2212x1659px.
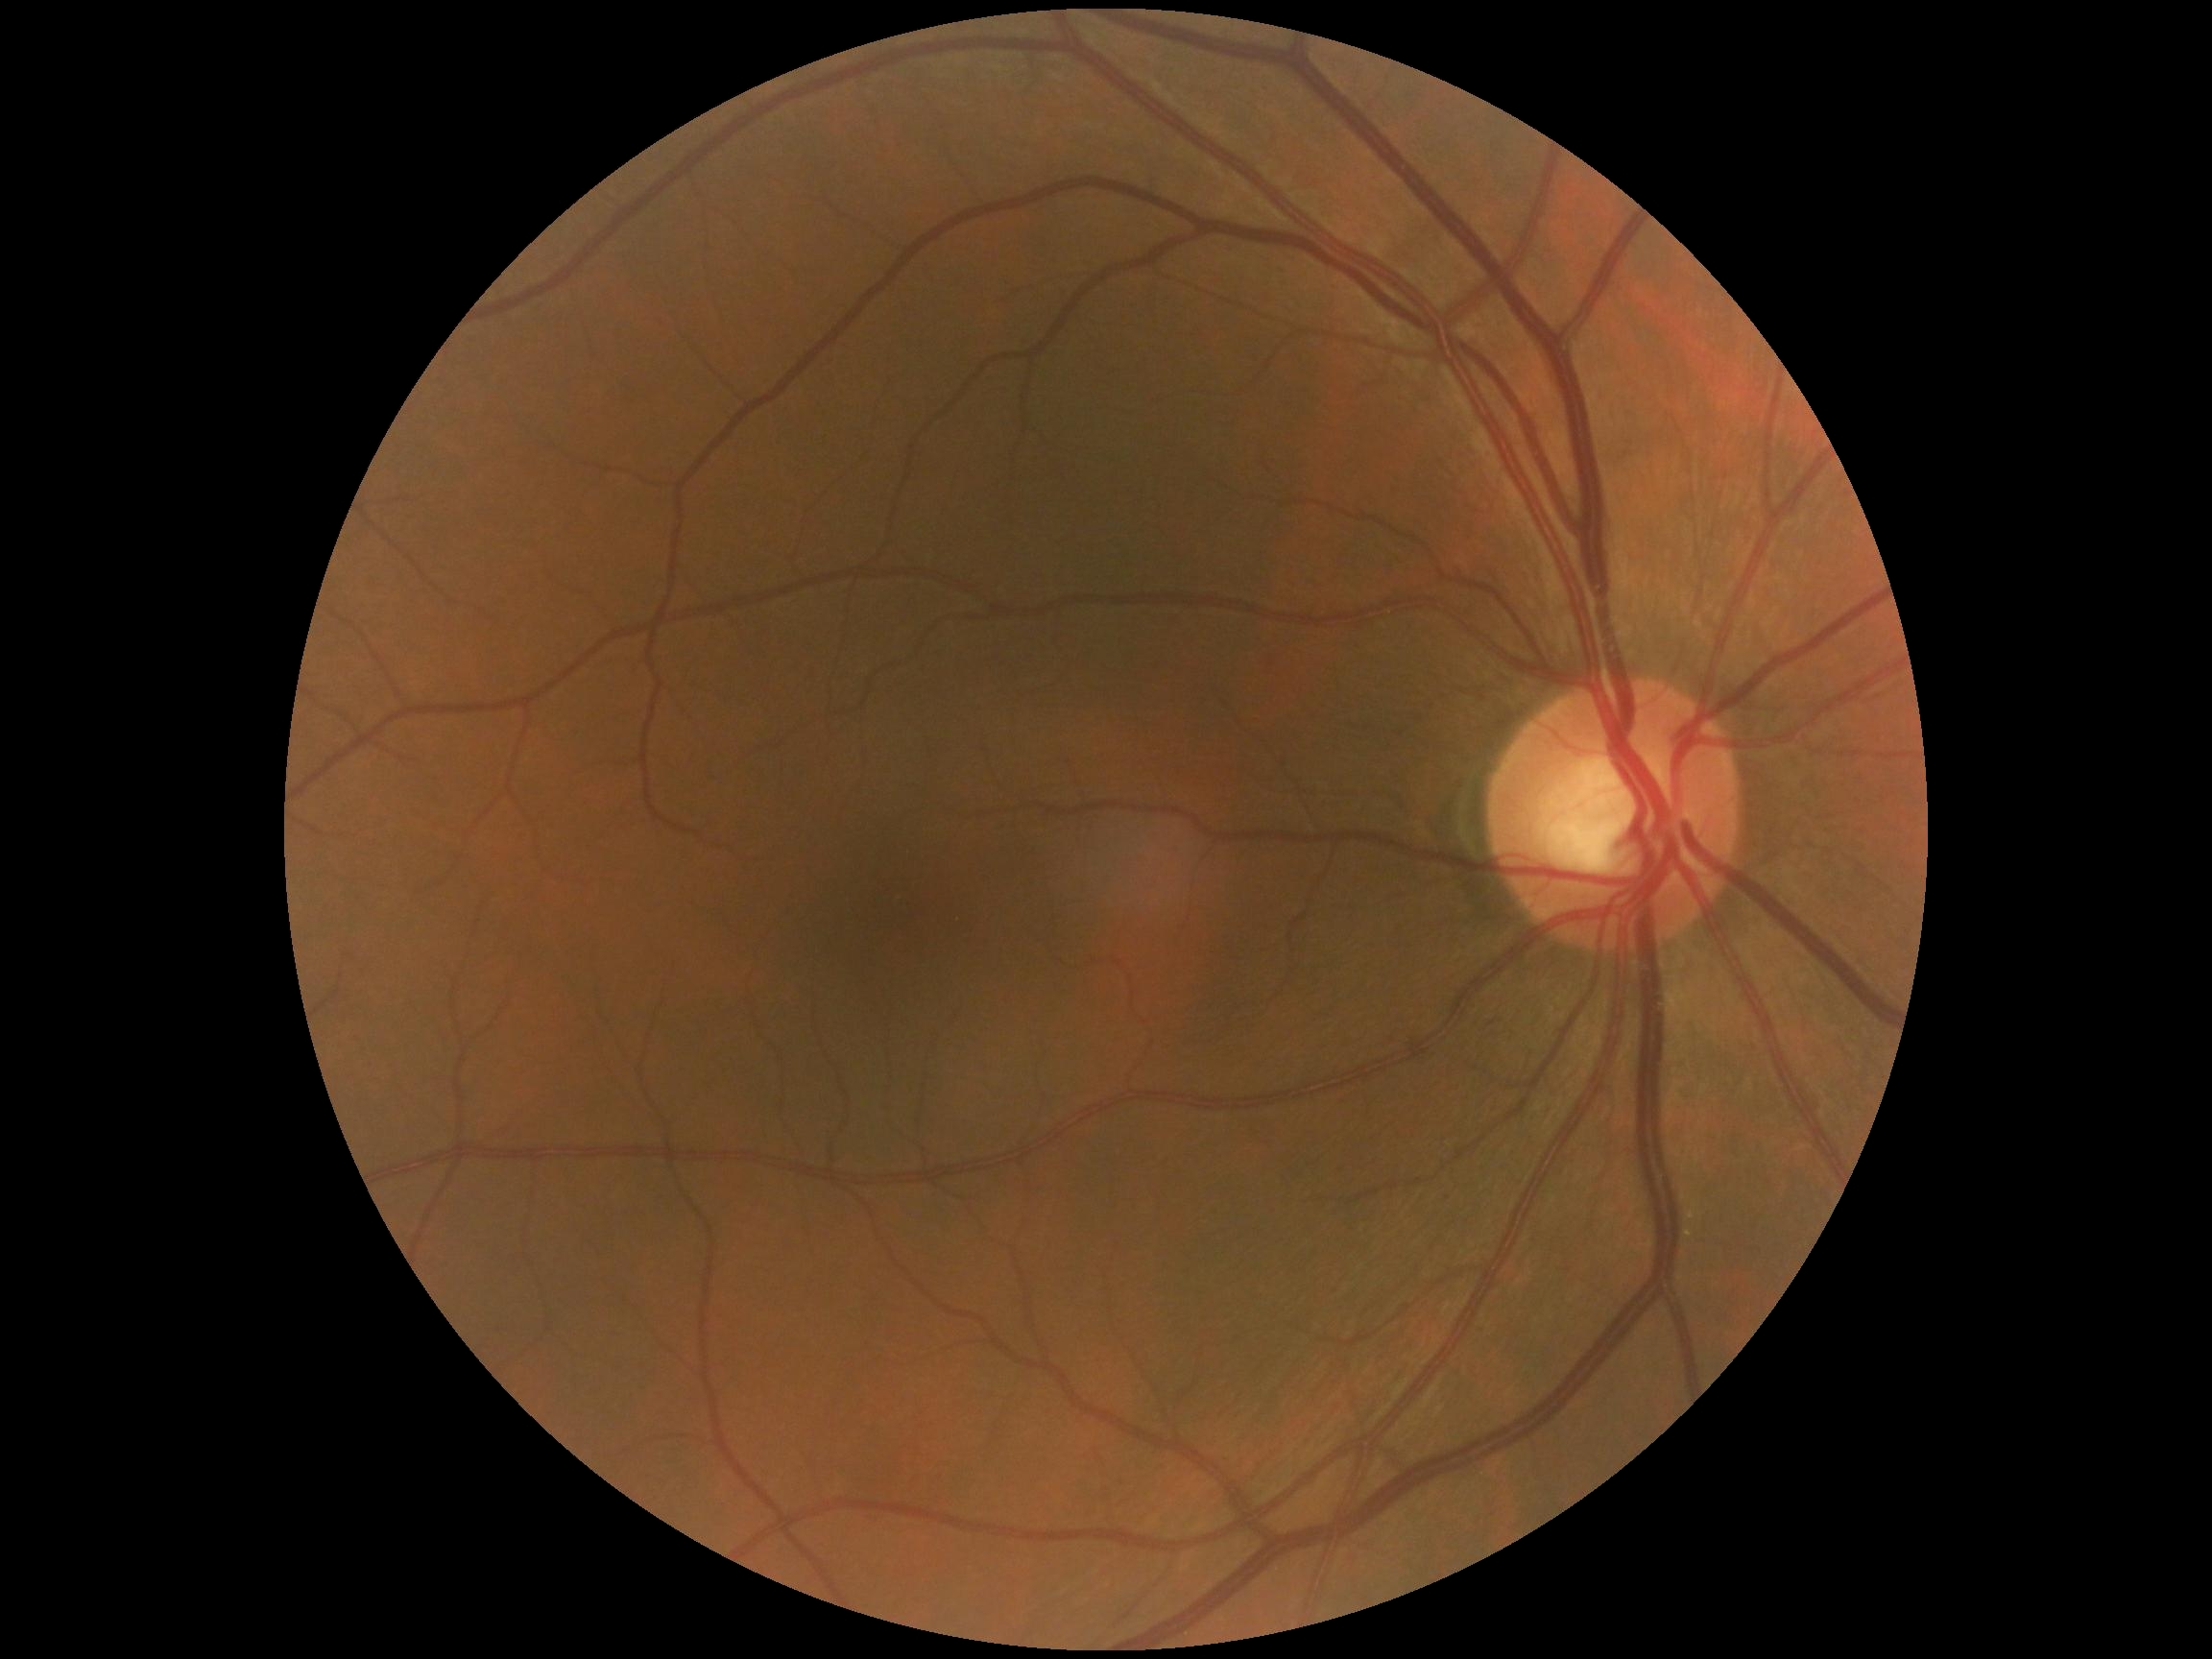 DR severity: no apparent retinopathy (grade 0) — no visible signs of diabetic retinopathy, DR impression: no DR findings.